Image size 2352x1568:
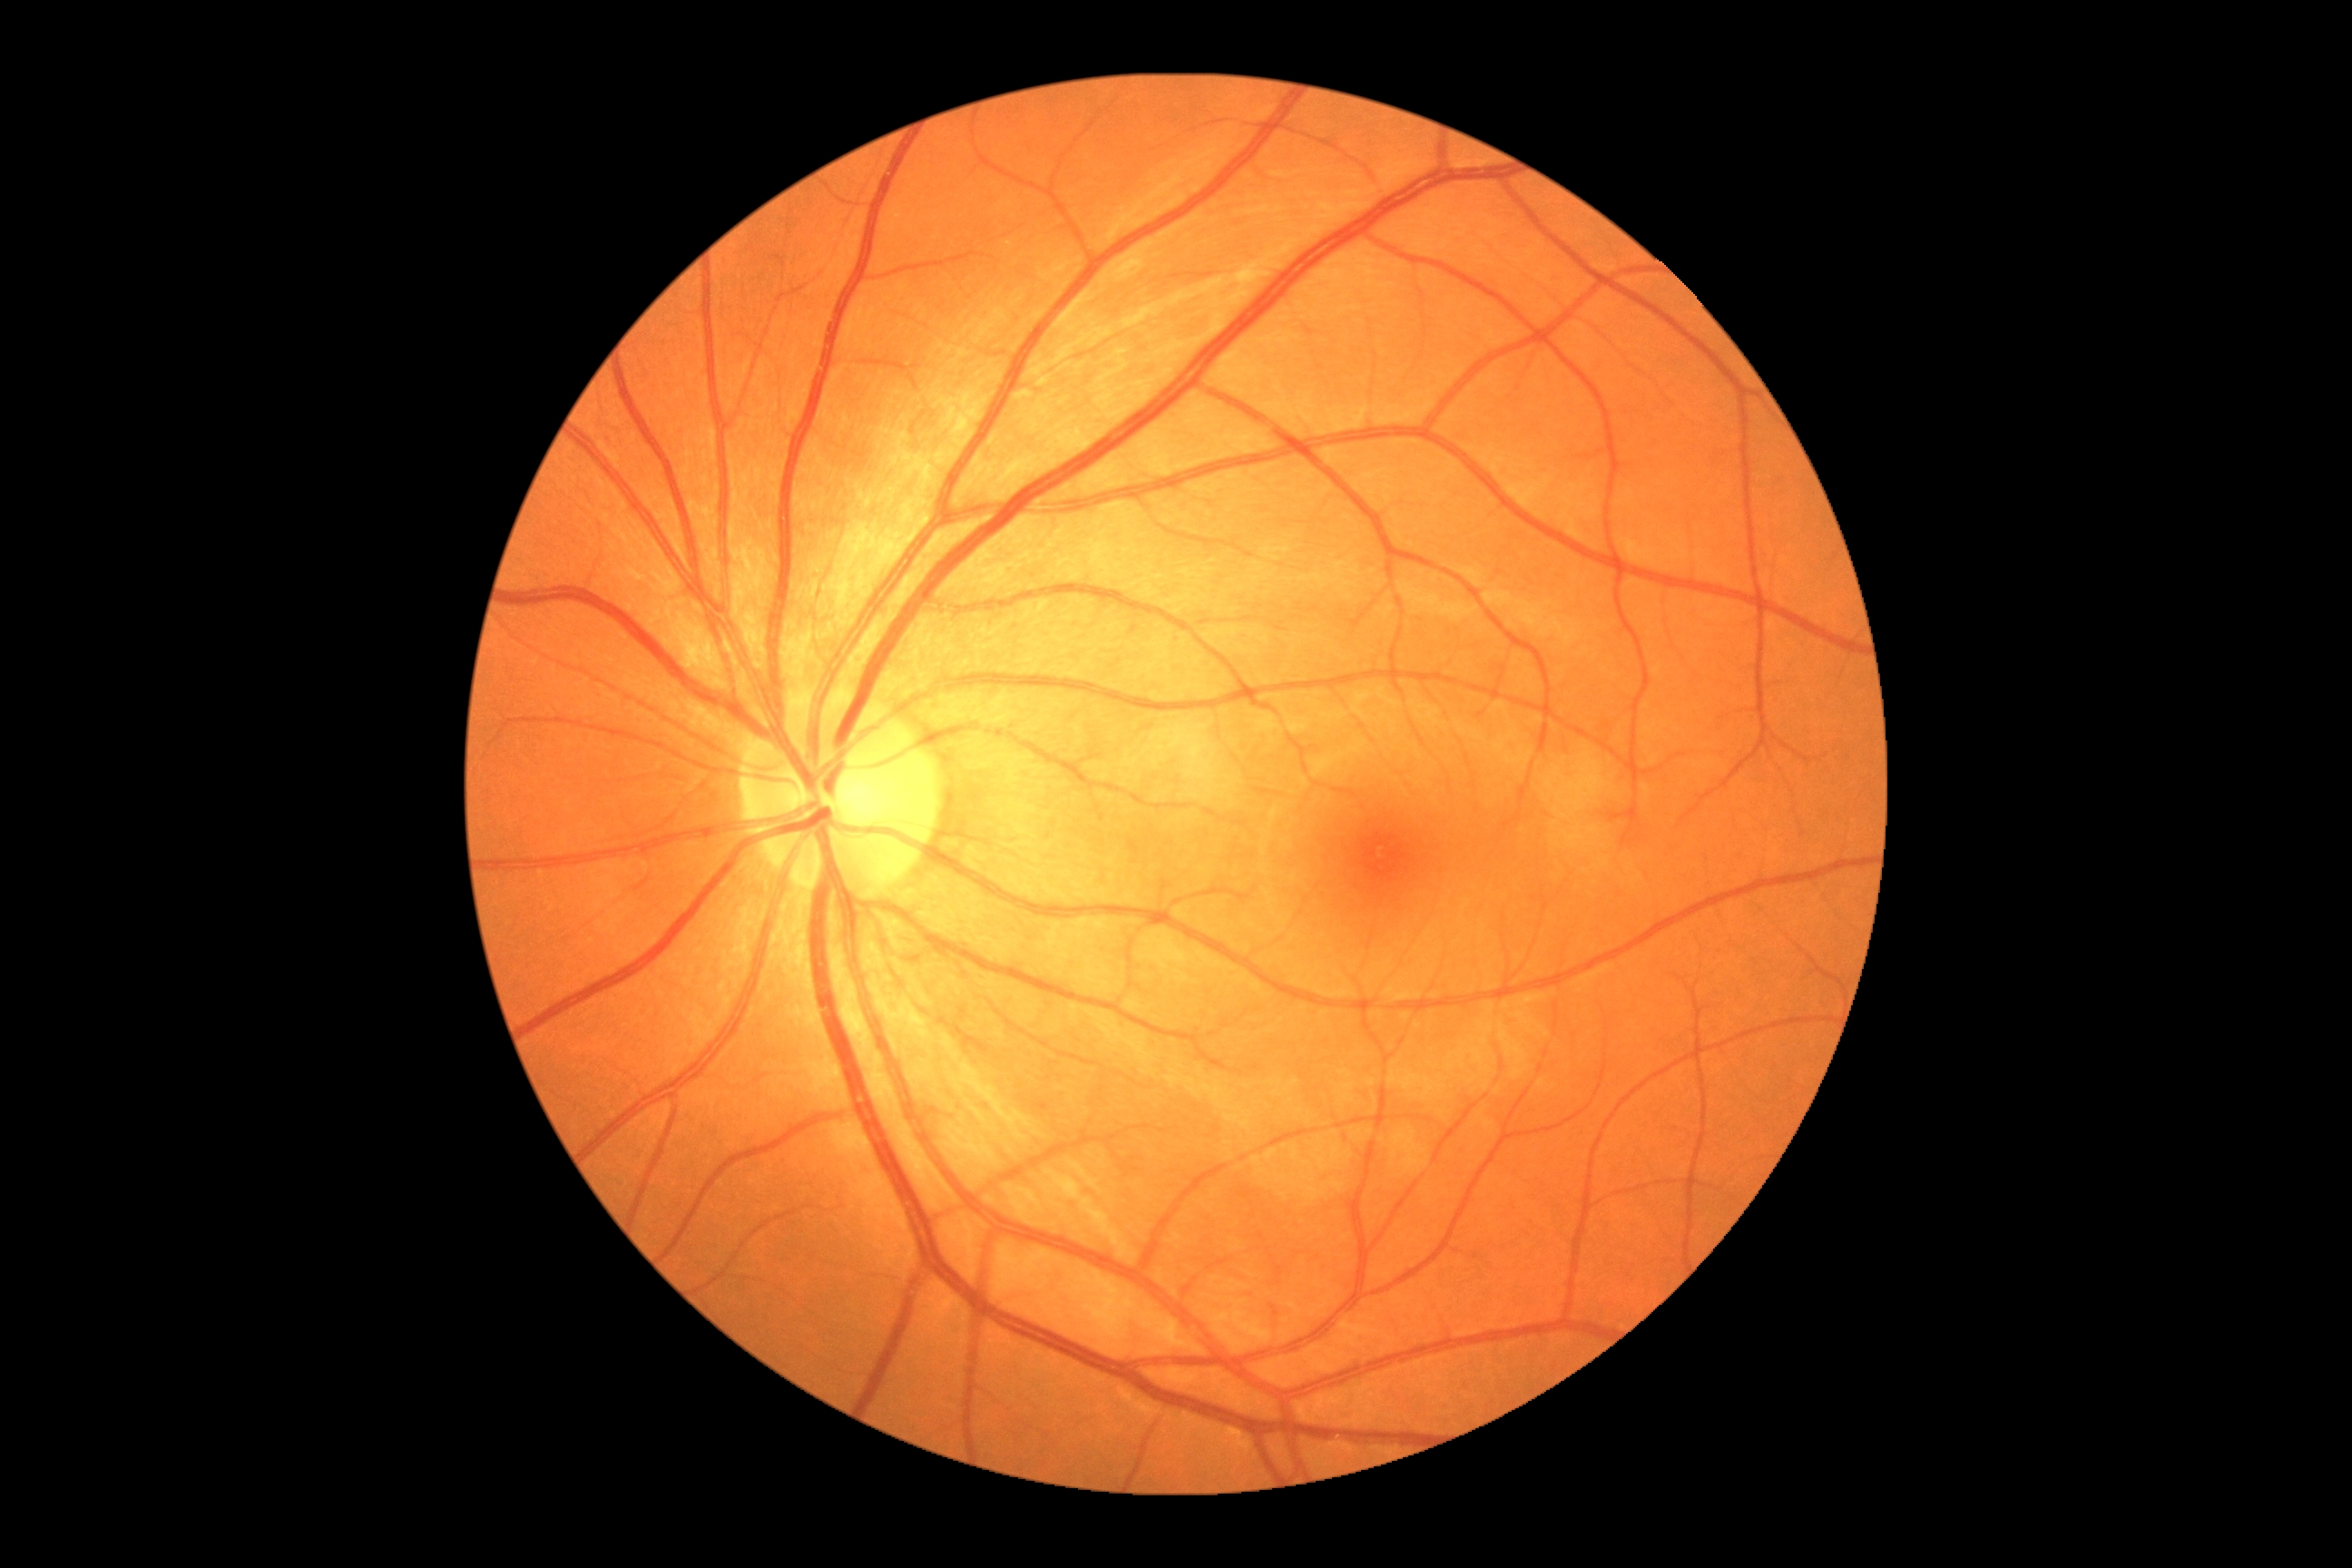 Retinopathy grade: 0.